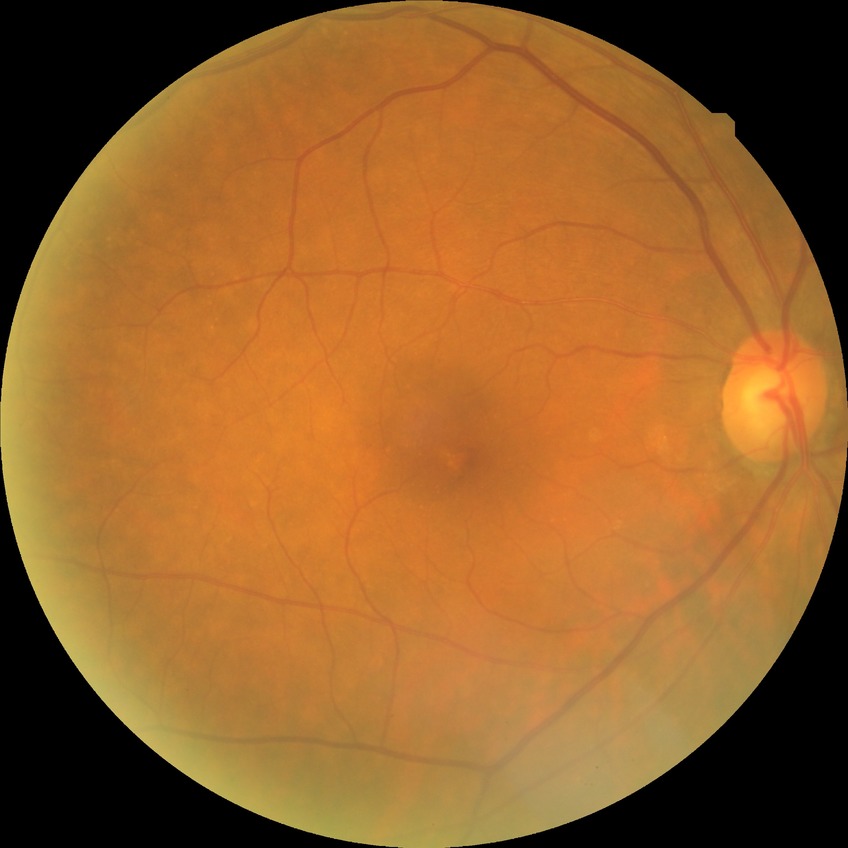
diabetic retinopathy (DR): NDR (no diabetic retinopathy).